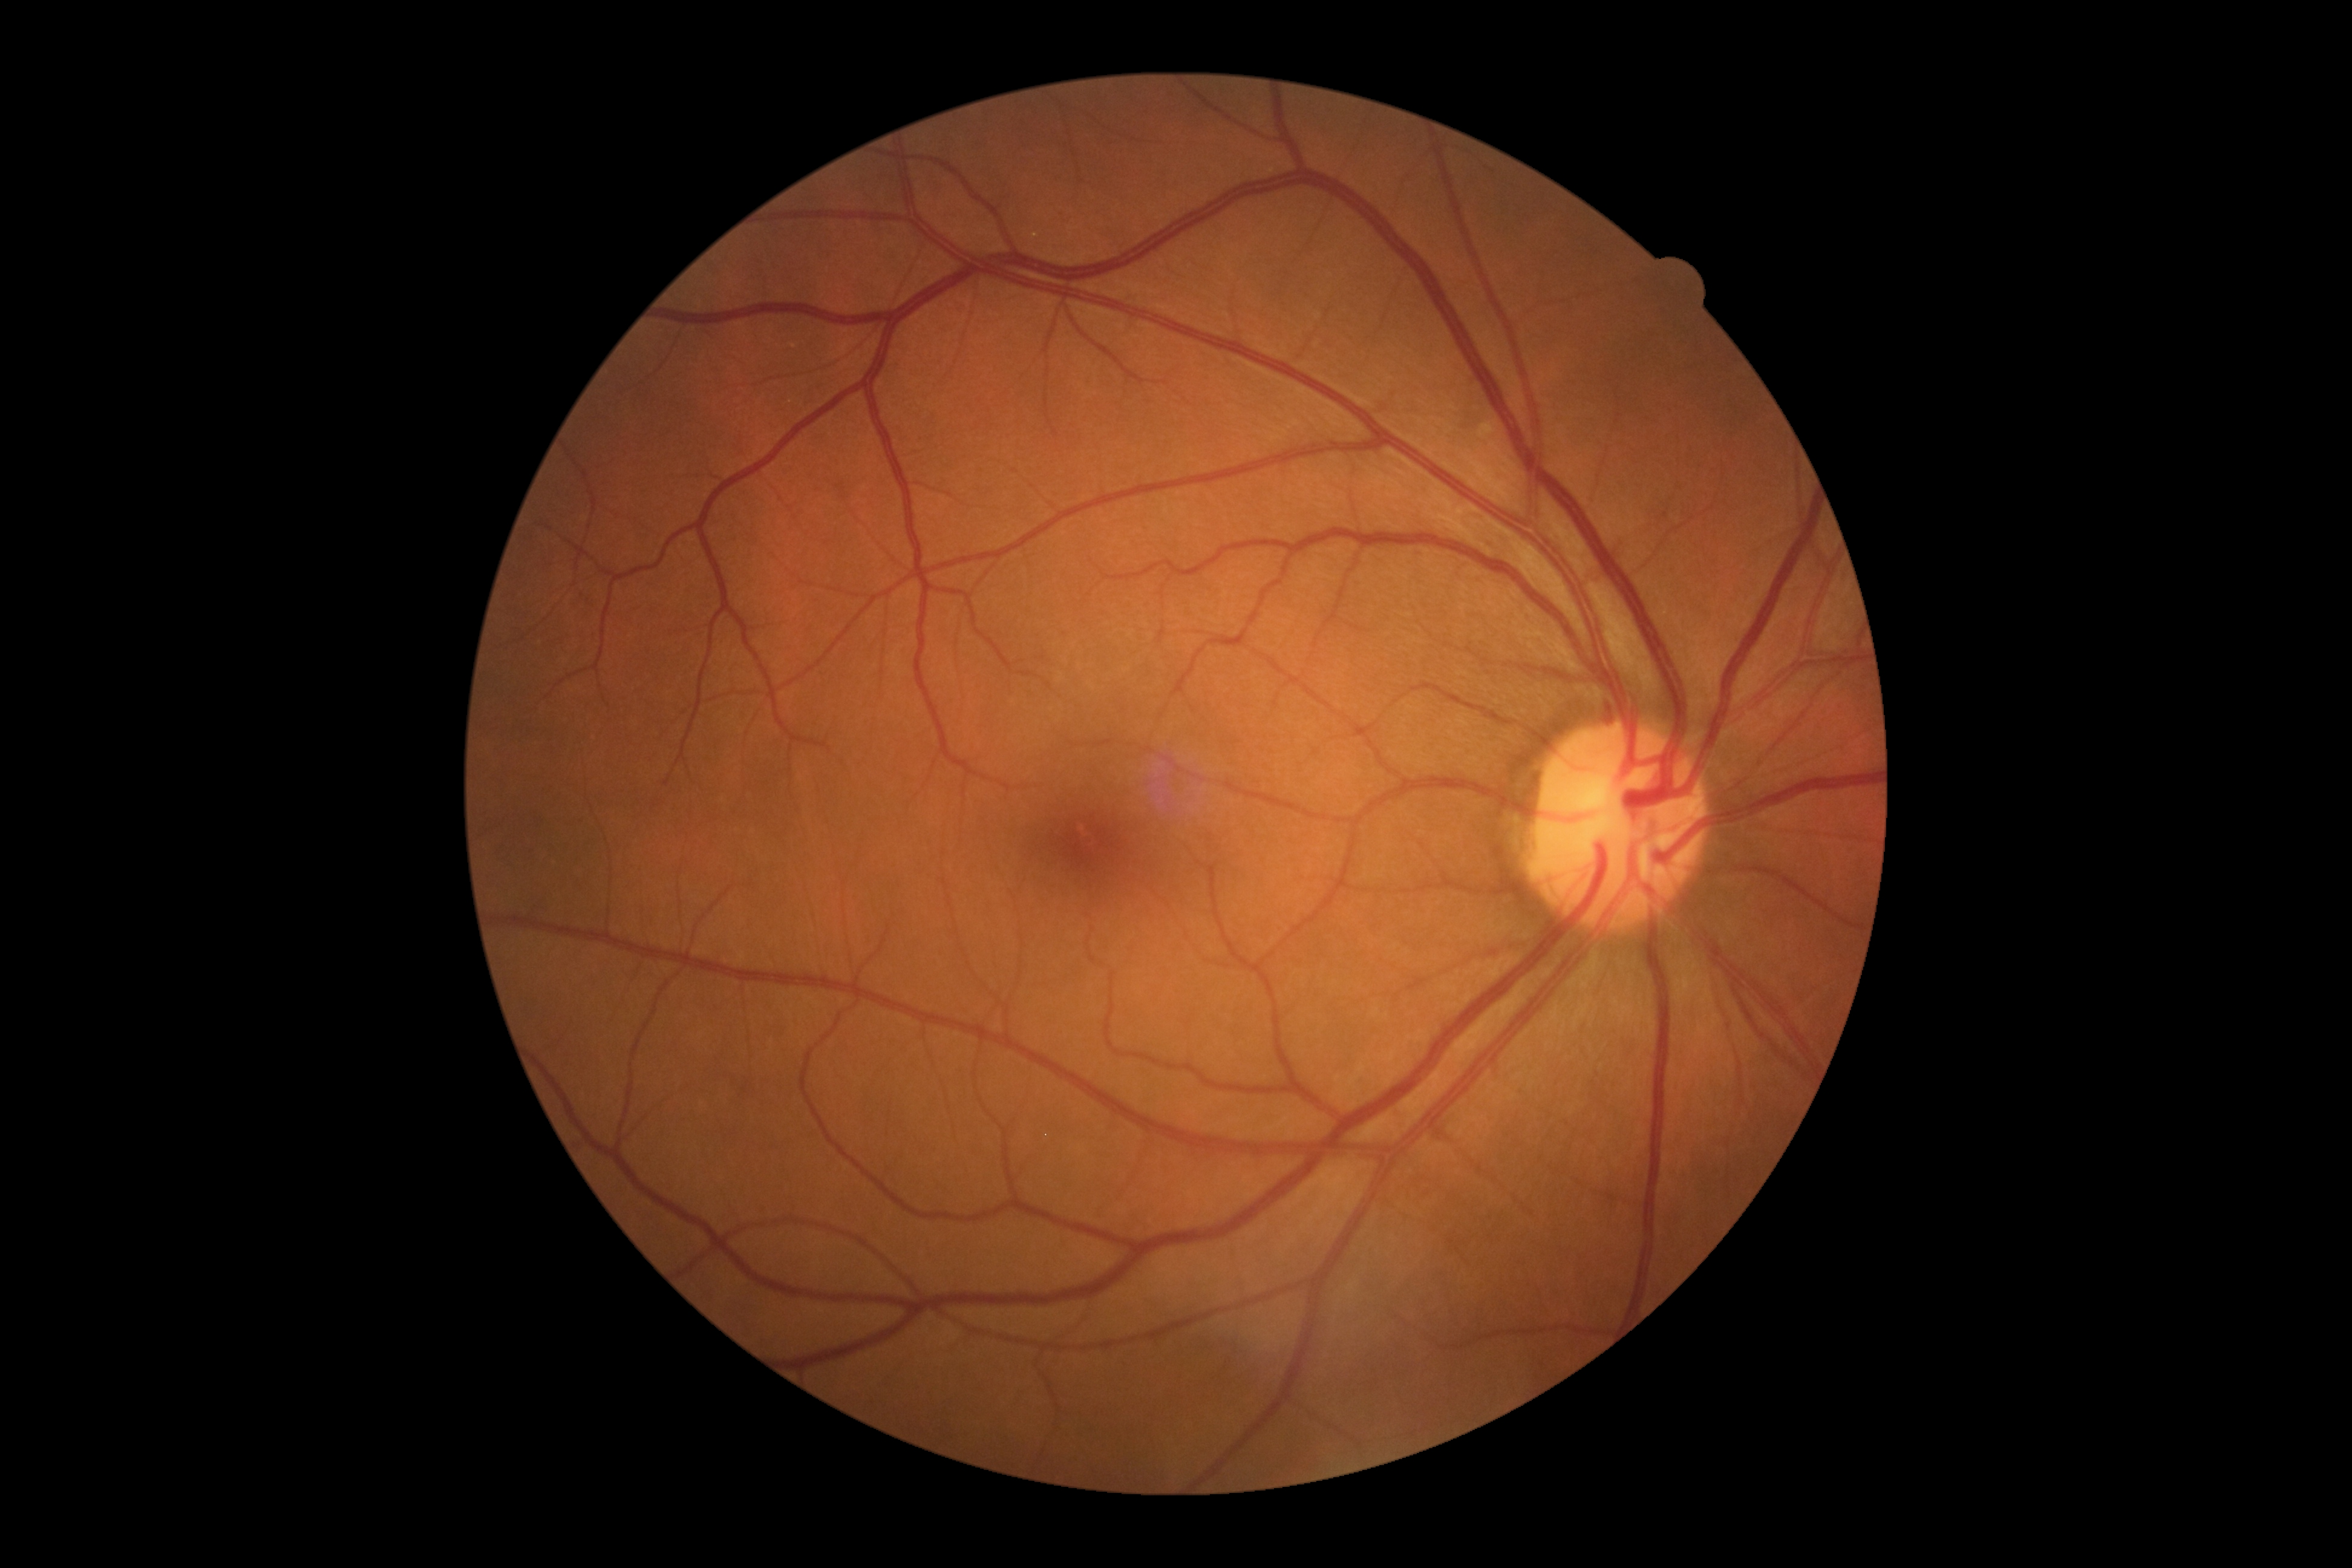
Retinopathy is 0/4.